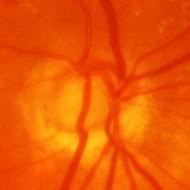 Glaucomatous optic neuropathy is present. Disc-centered fundus crop showing glaucomatous findings.